Infant wide-field fundus photograph: 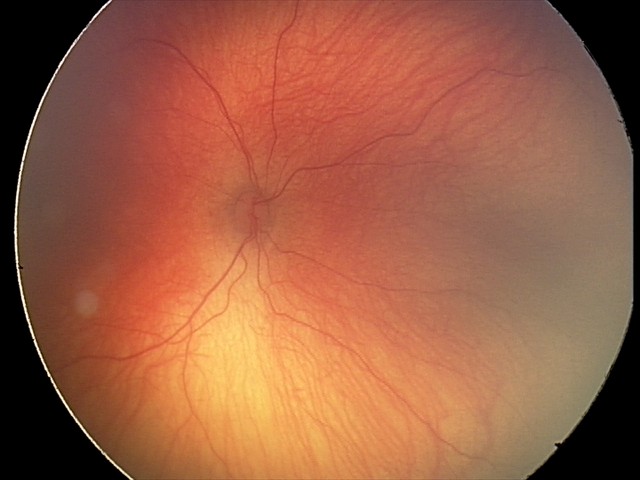 Q: Is plus disease present?
A: no plus disease — posterior pole vessels without abnormal dilation or tortuosity
Q: What is the screening diagnosis?
A: retinopathy of prematurity stage 2